2352x1568px · 45° FOV.
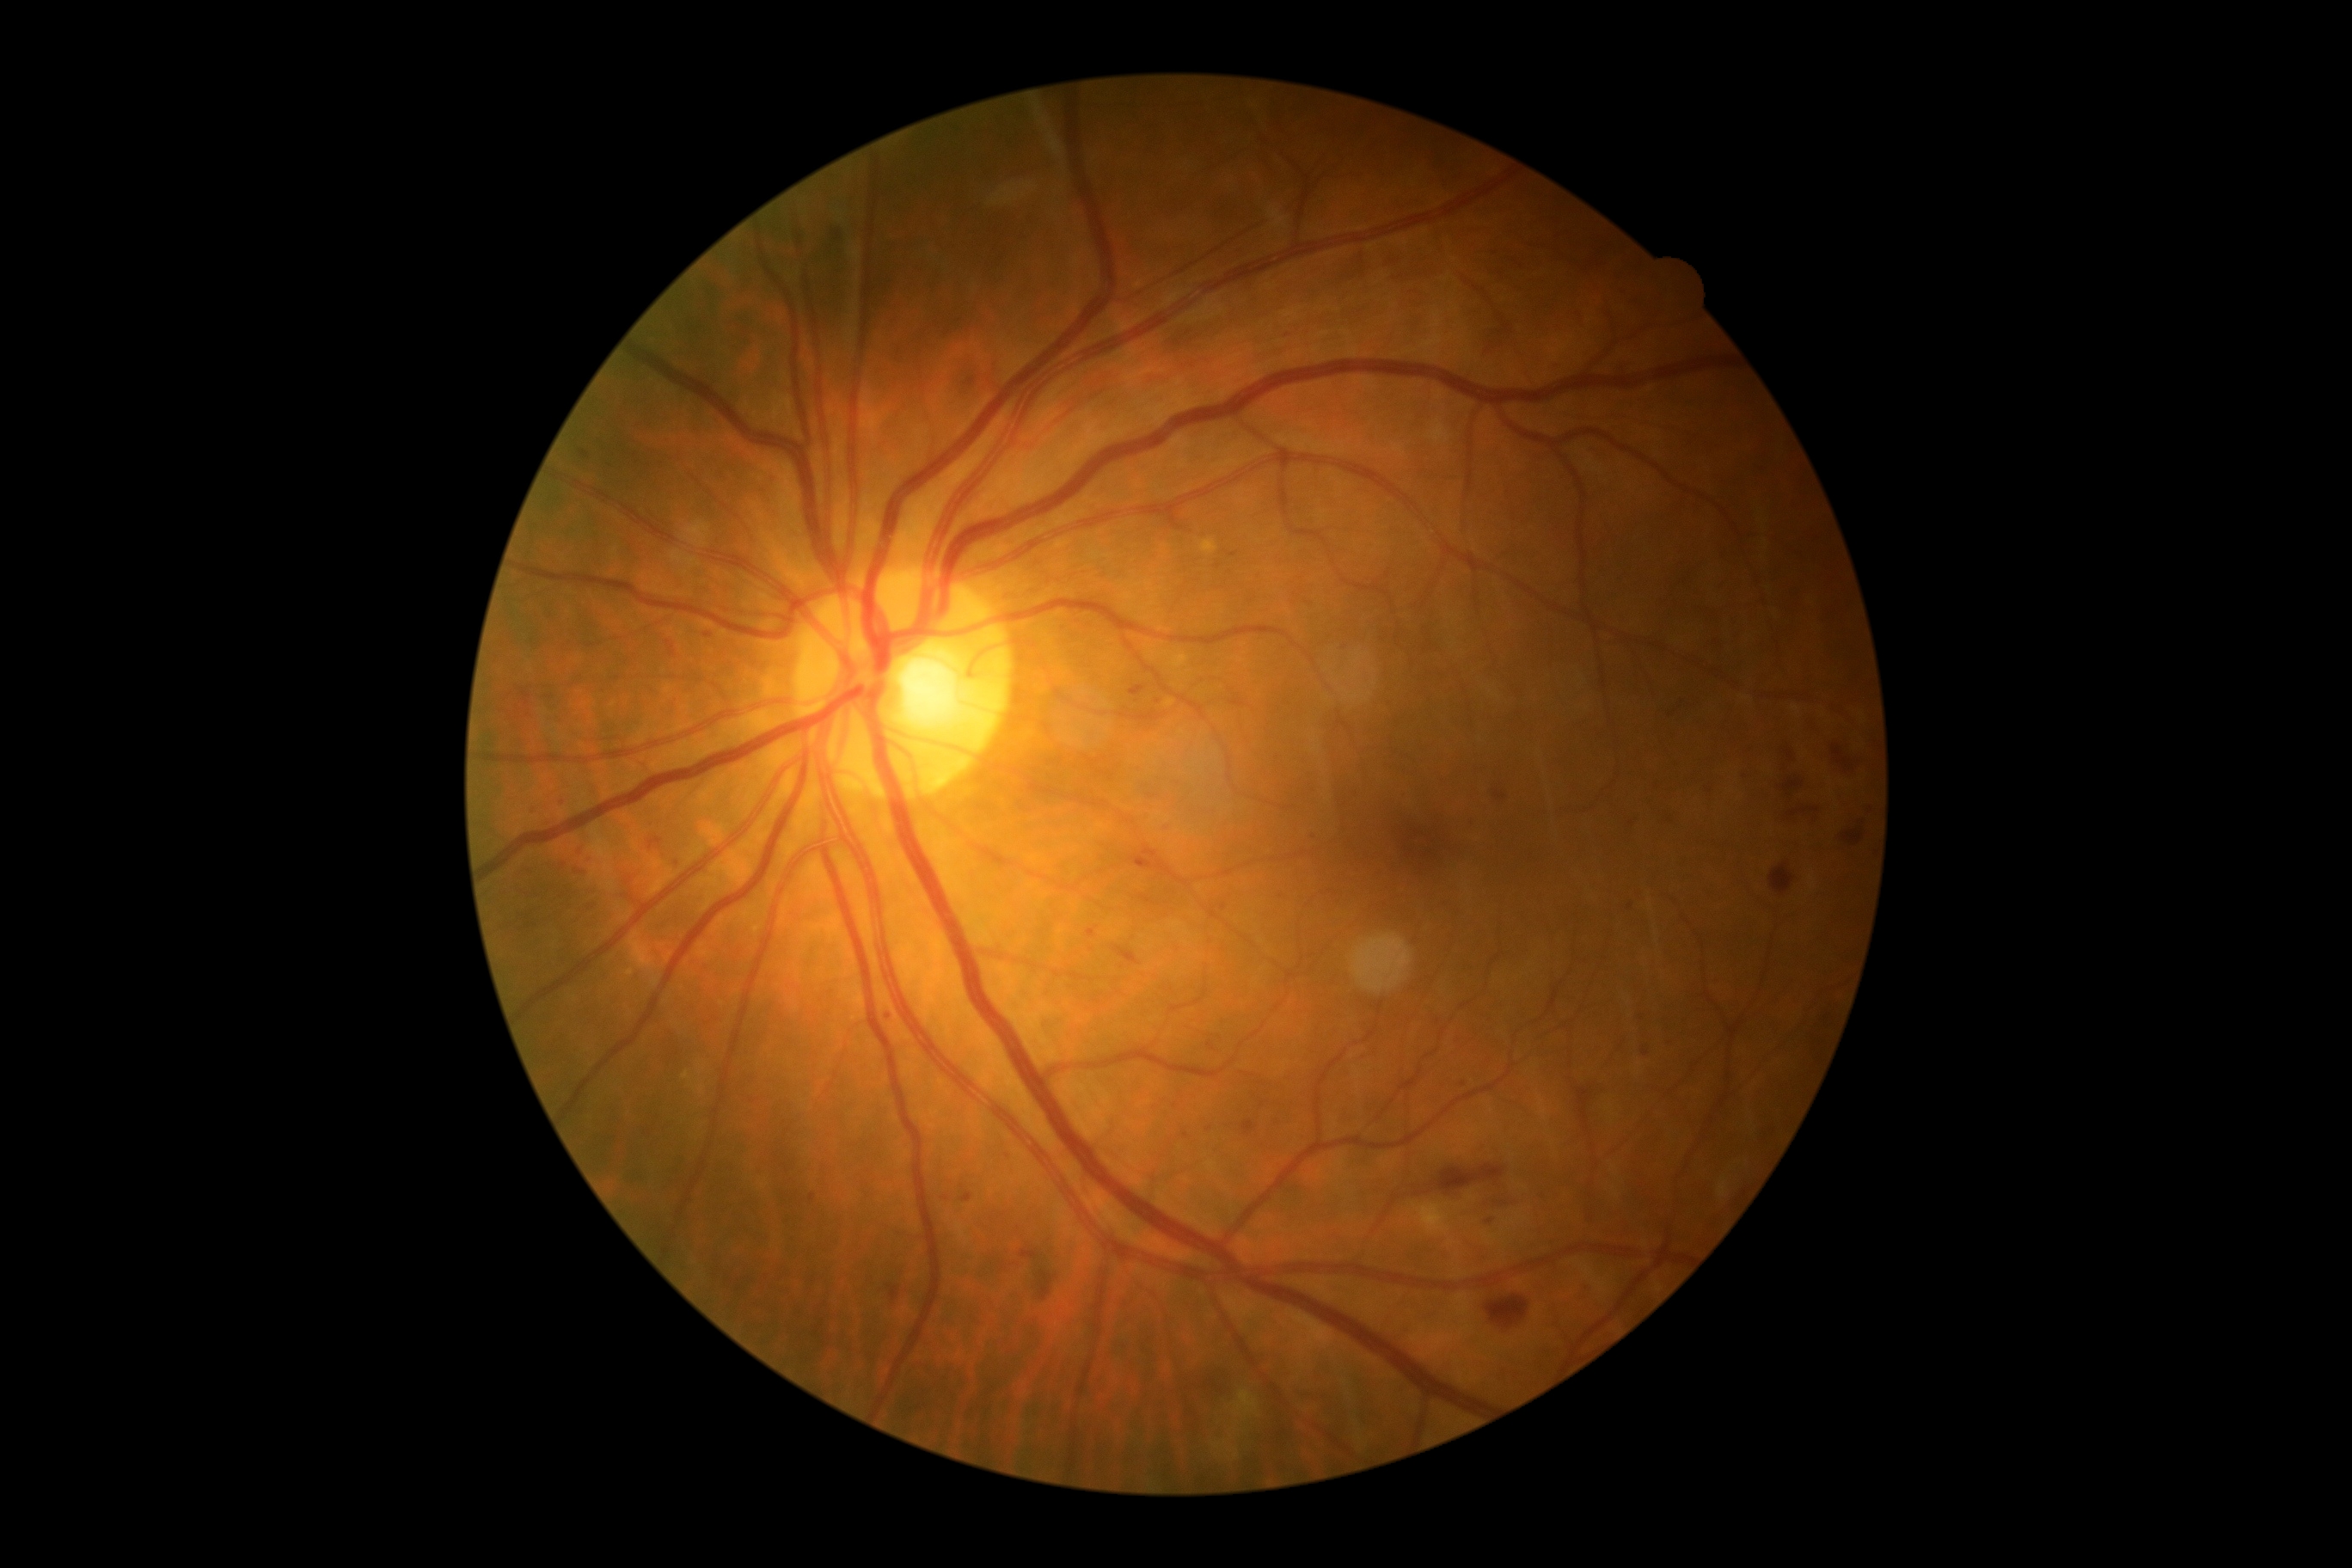

Retinopathy is 2
Representative lesions:
microaneurysms (continued): {"x1": 960, "y1": 1192, "x2": 972, "y2": 1203} | {"x1": 647, "y1": 838, "x2": 665, "y2": 850} | {"x1": 580, "y1": 451, "x2": 591, "y2": 458} | {"x1": 1129, "y1": 685, "x2": 1148, "y2": 697} | {"x1": 1149, "y1": 793, "x2": 1158, "y2": 800} | {"x1": 704, "y1": 634, "x2": 713, "y2": 639} | {"x1": 1220, "y1": 903, "x2": 1228, "y2": 910} | {"x1": 831, "y1": 231, "x2": 842, "y2": 242}
Small microaneurysms approximately at (888; 1017) | (1464; 1084) | (1186; 1135) | (677; 864) | (589; 907)